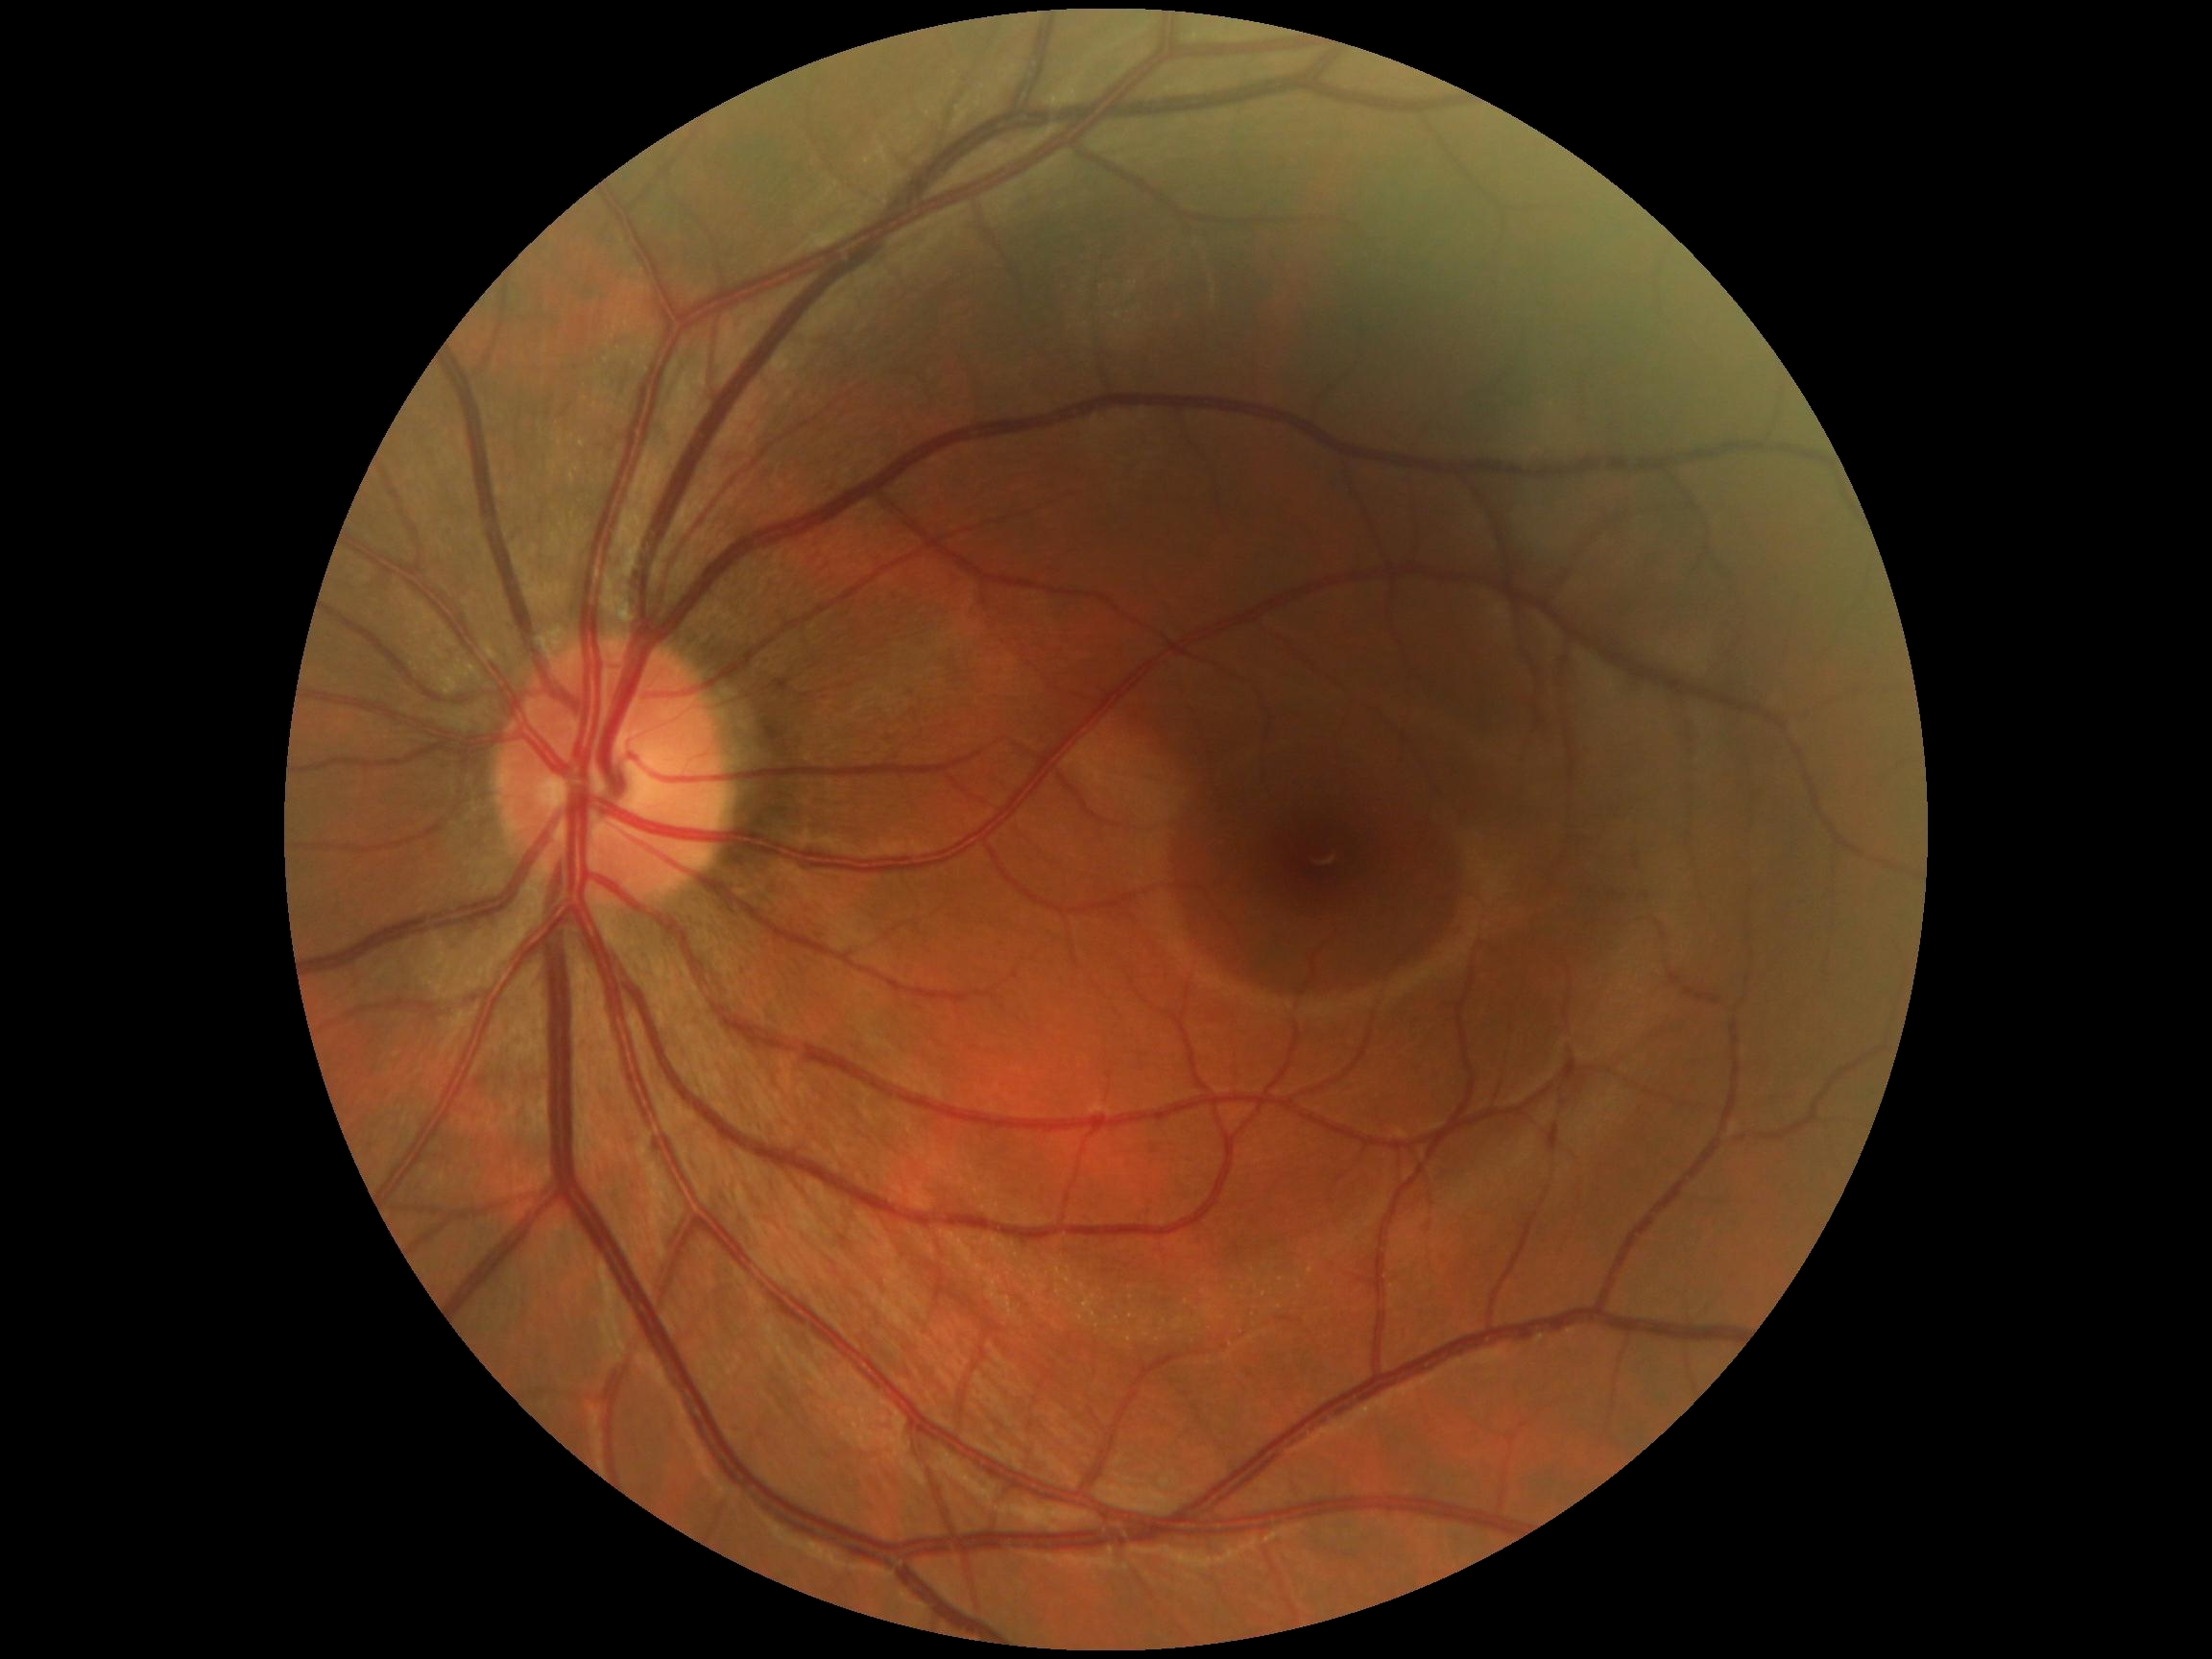 Retinopathy grade: 0 — no visible signs of diabetic retinopathy.